1240x1240. Pediatric retinal photograph (wide-field):
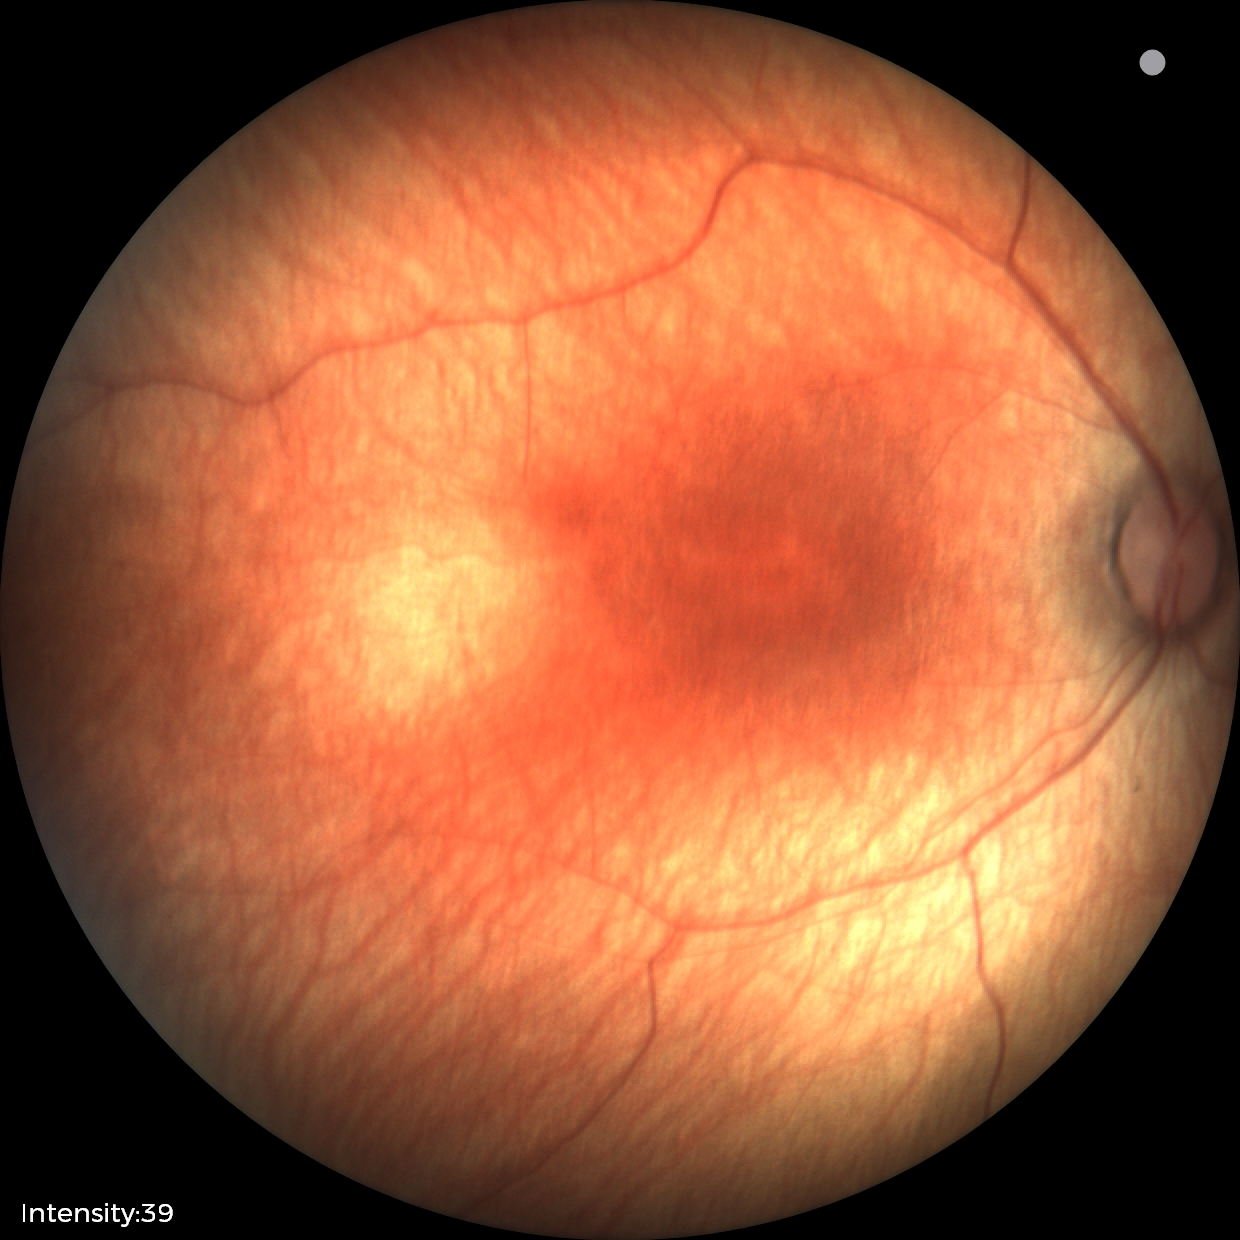 Q: What was the screening finding?
A: physiological retinal finding